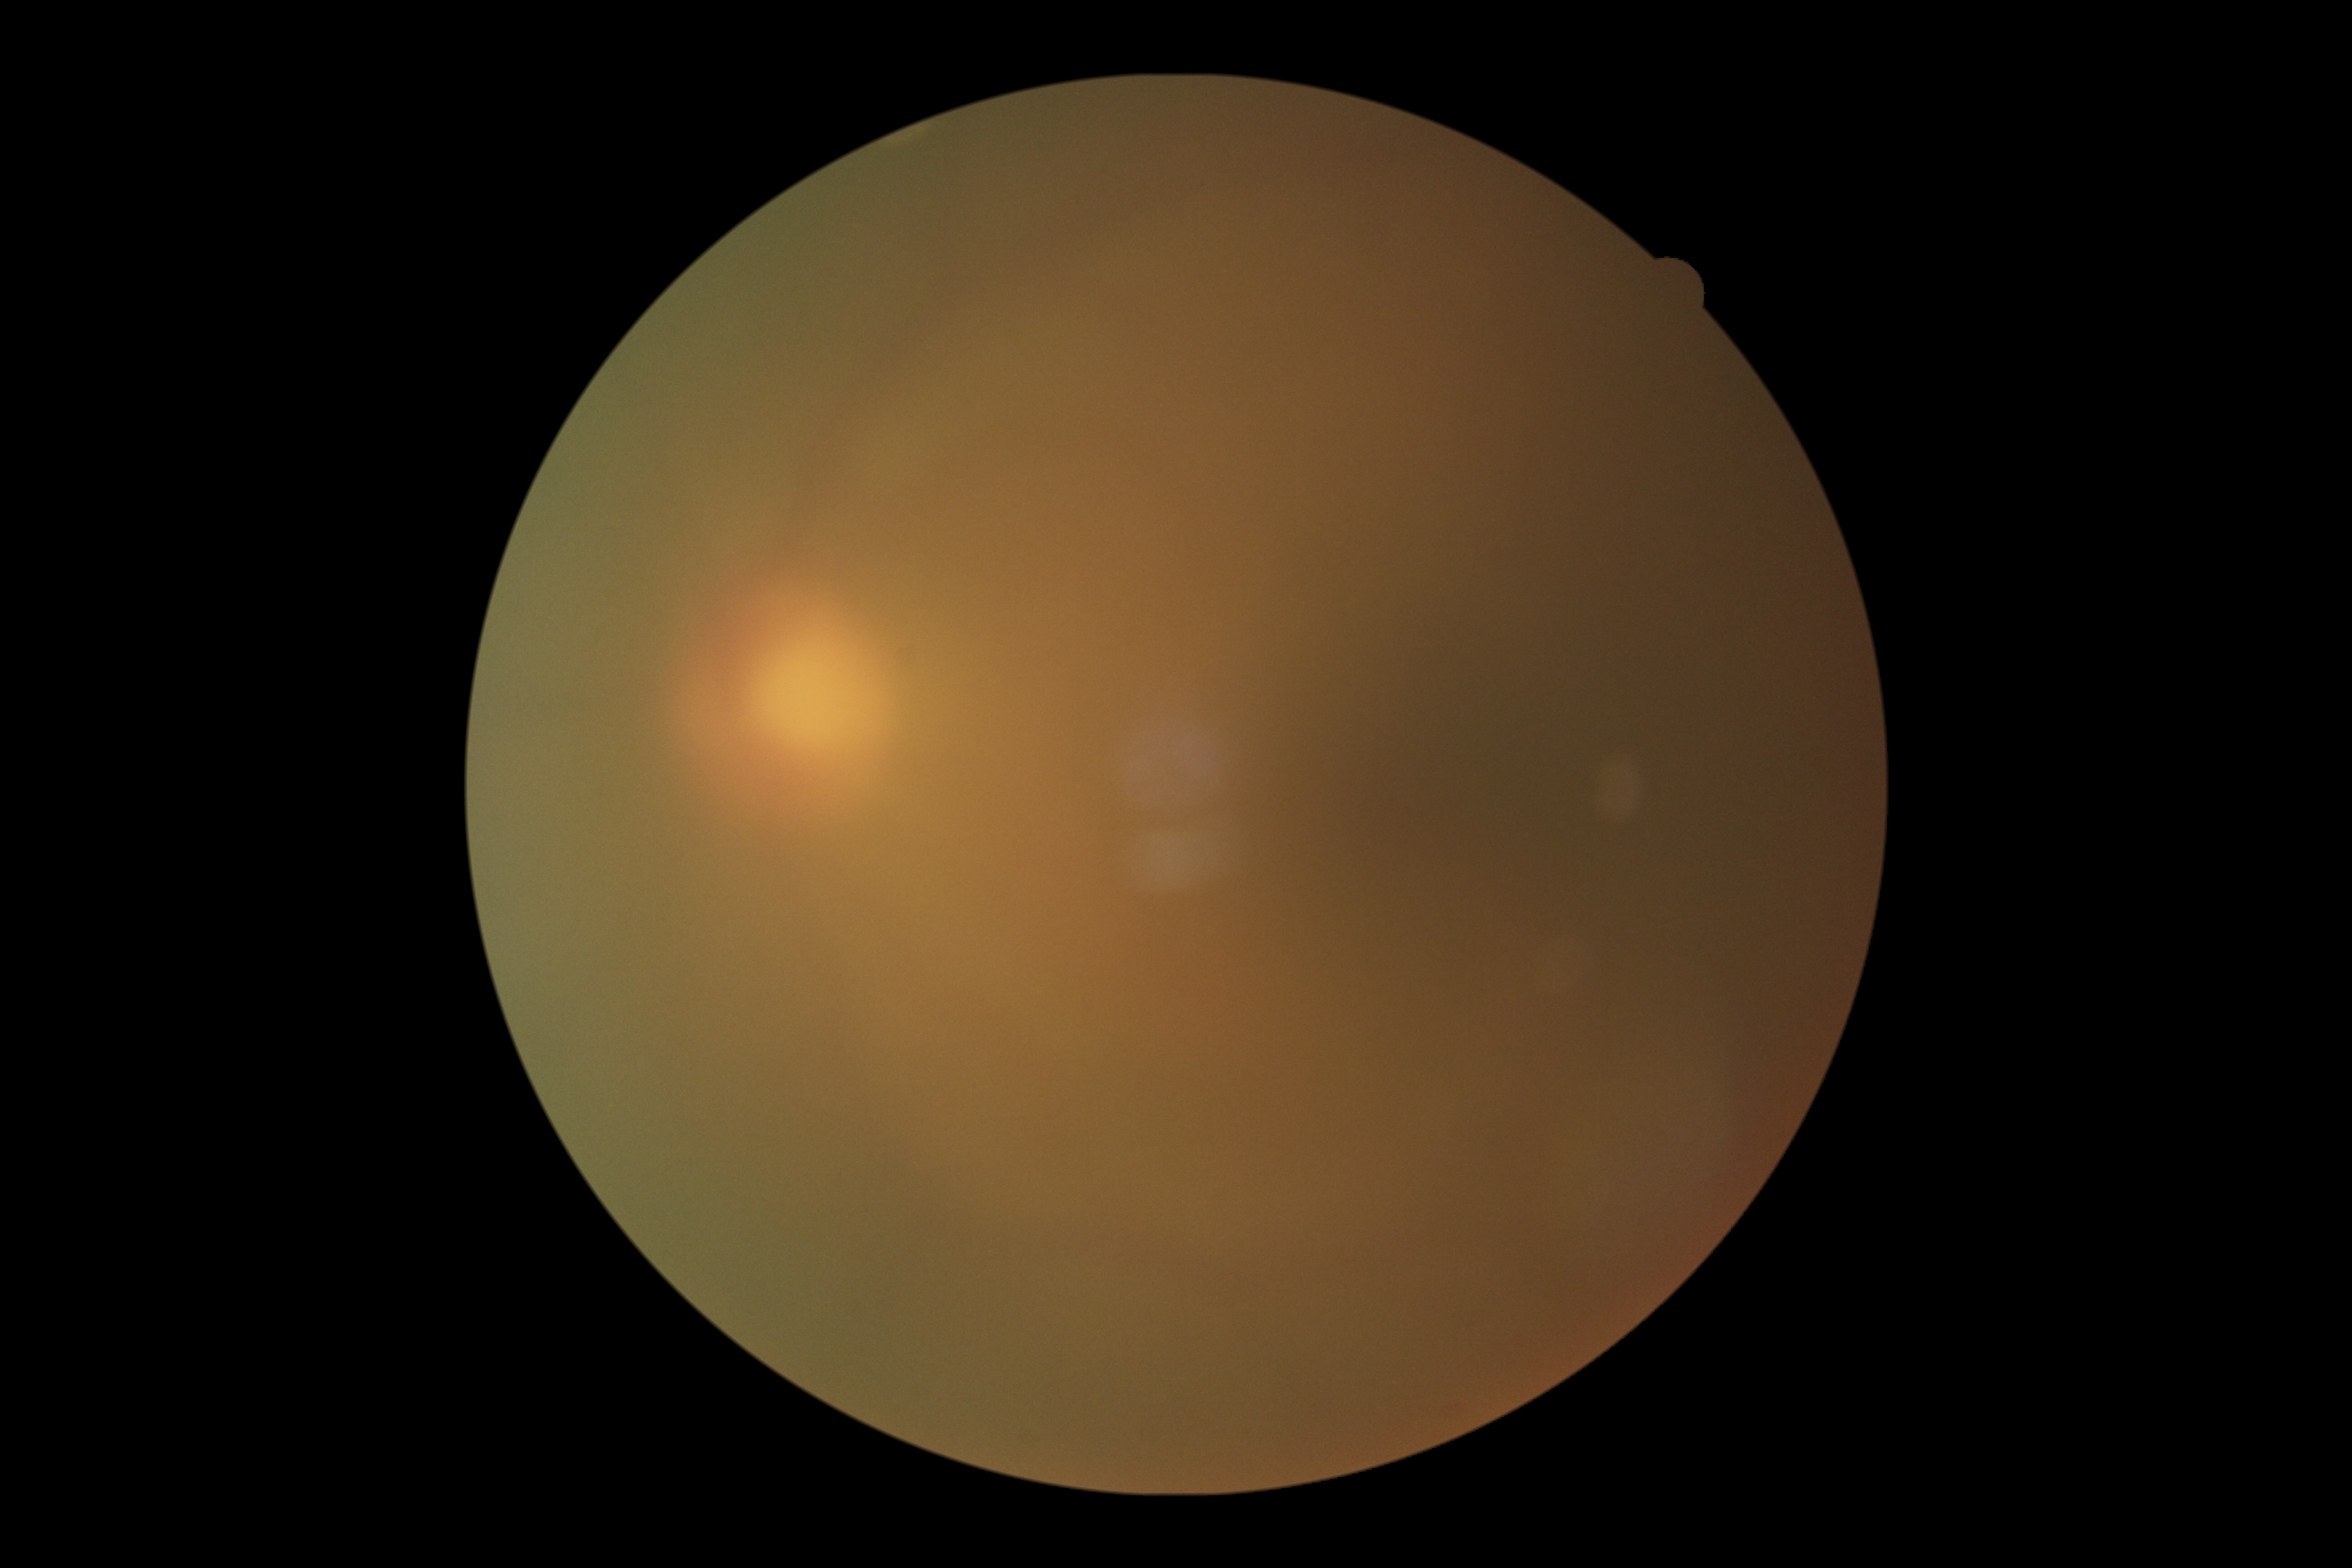
- image quality: below grading threshold
- DR stage: ungradable